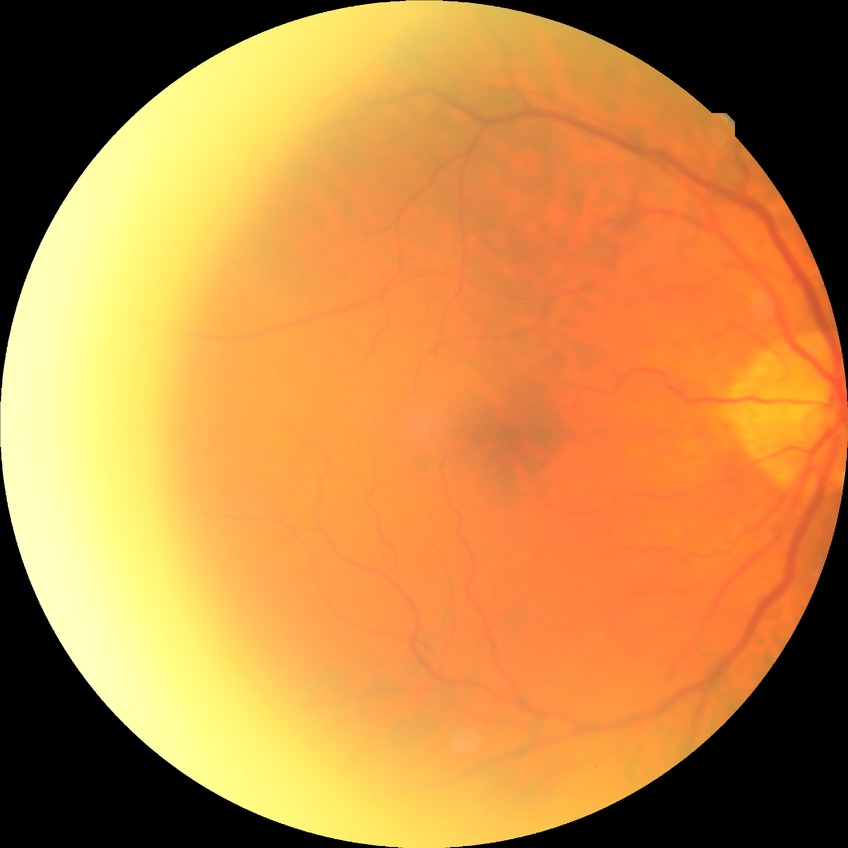 Modified Davis grading: no diabetic retinopathy.